1240 x 1240 pixels; infant wide-field retinal image.
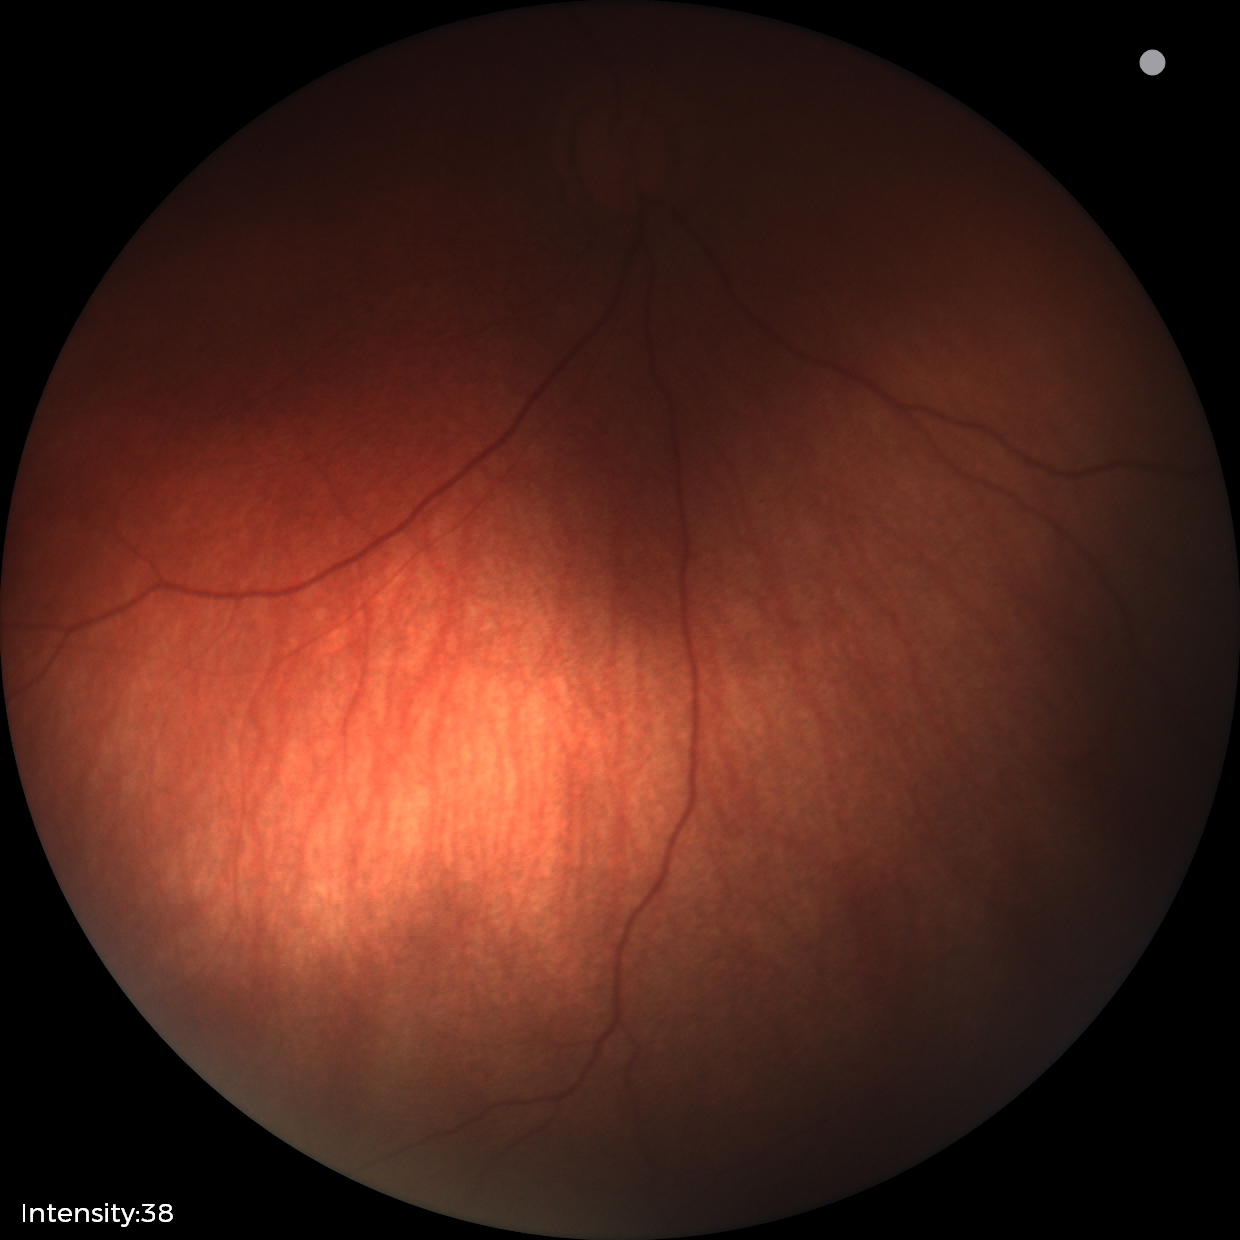
Q: What is the screening diagnosis?
A: physiological appearance with no retinal pathology